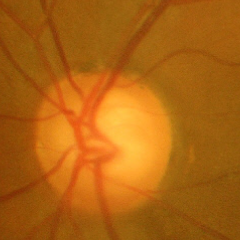
Glaucomatous changes are present. Glaucoma stage = advanced-stage glaucoma. Diagnostic criteria: near-total cupping of the optic nerve head, with or without severe visual field loss within the central 10 degrees of fixation.